CFP · 2089x1764px
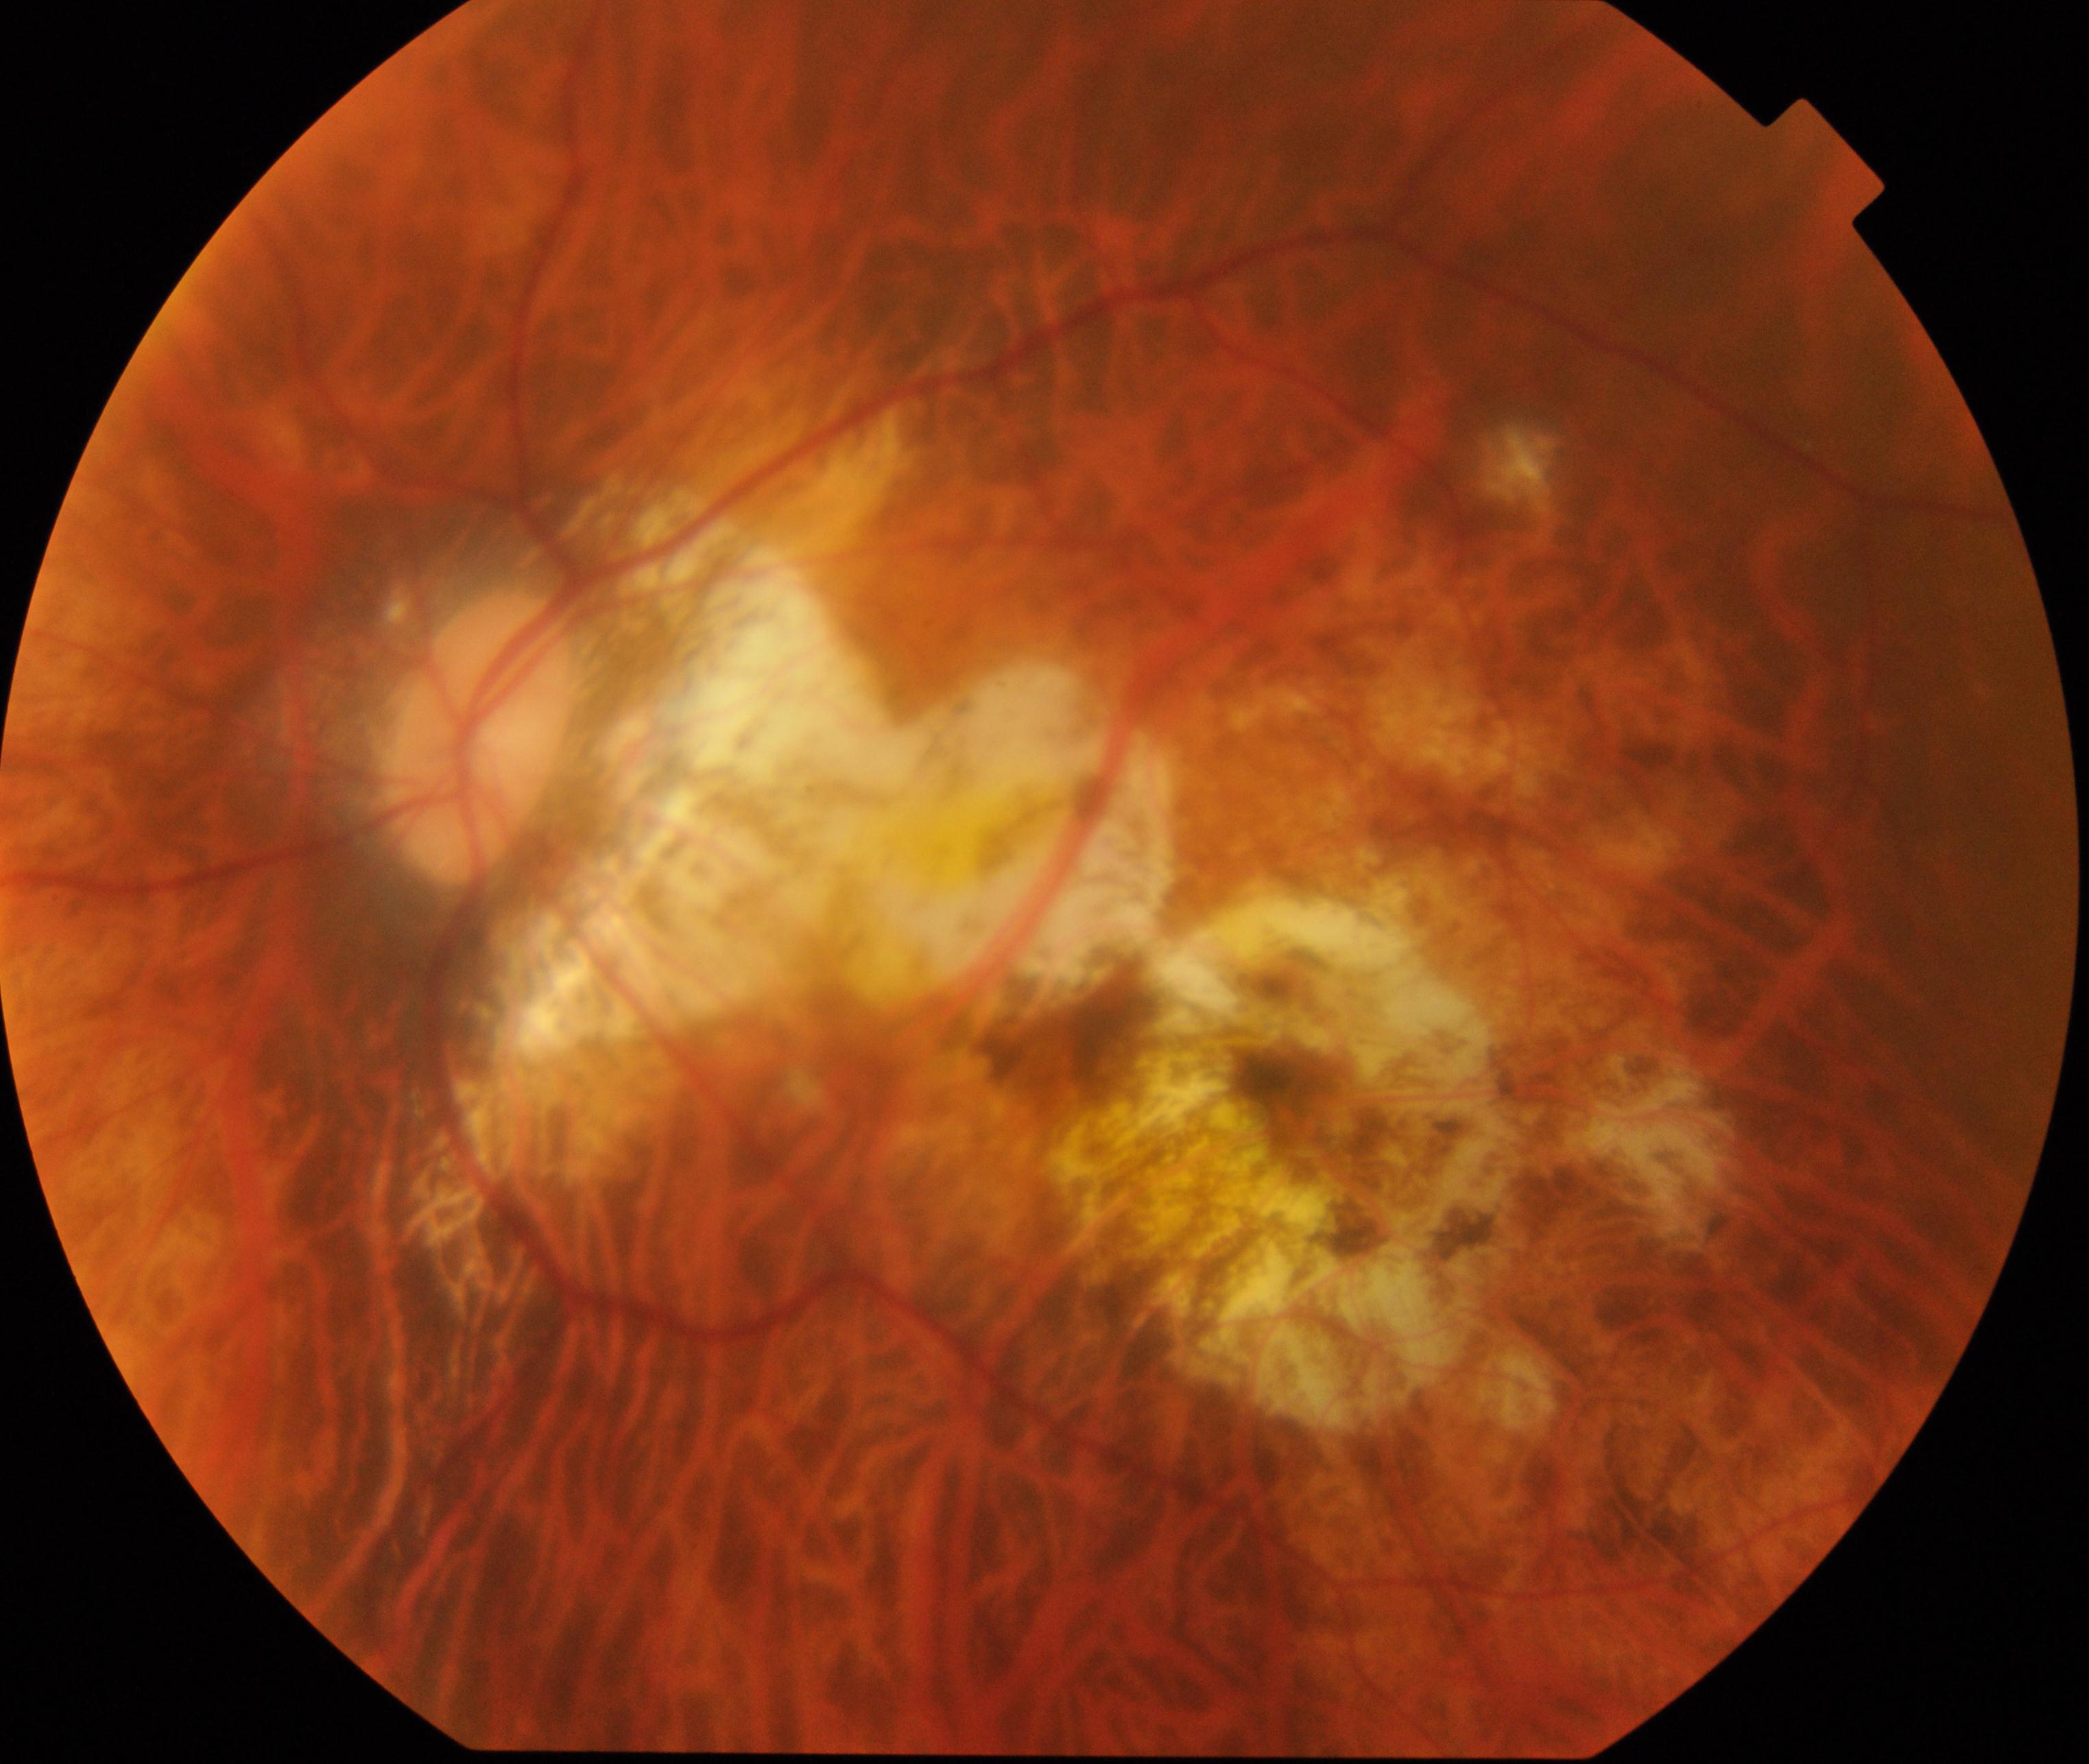 Demonstrates pathological myopia.